2048 x 1536 pixels
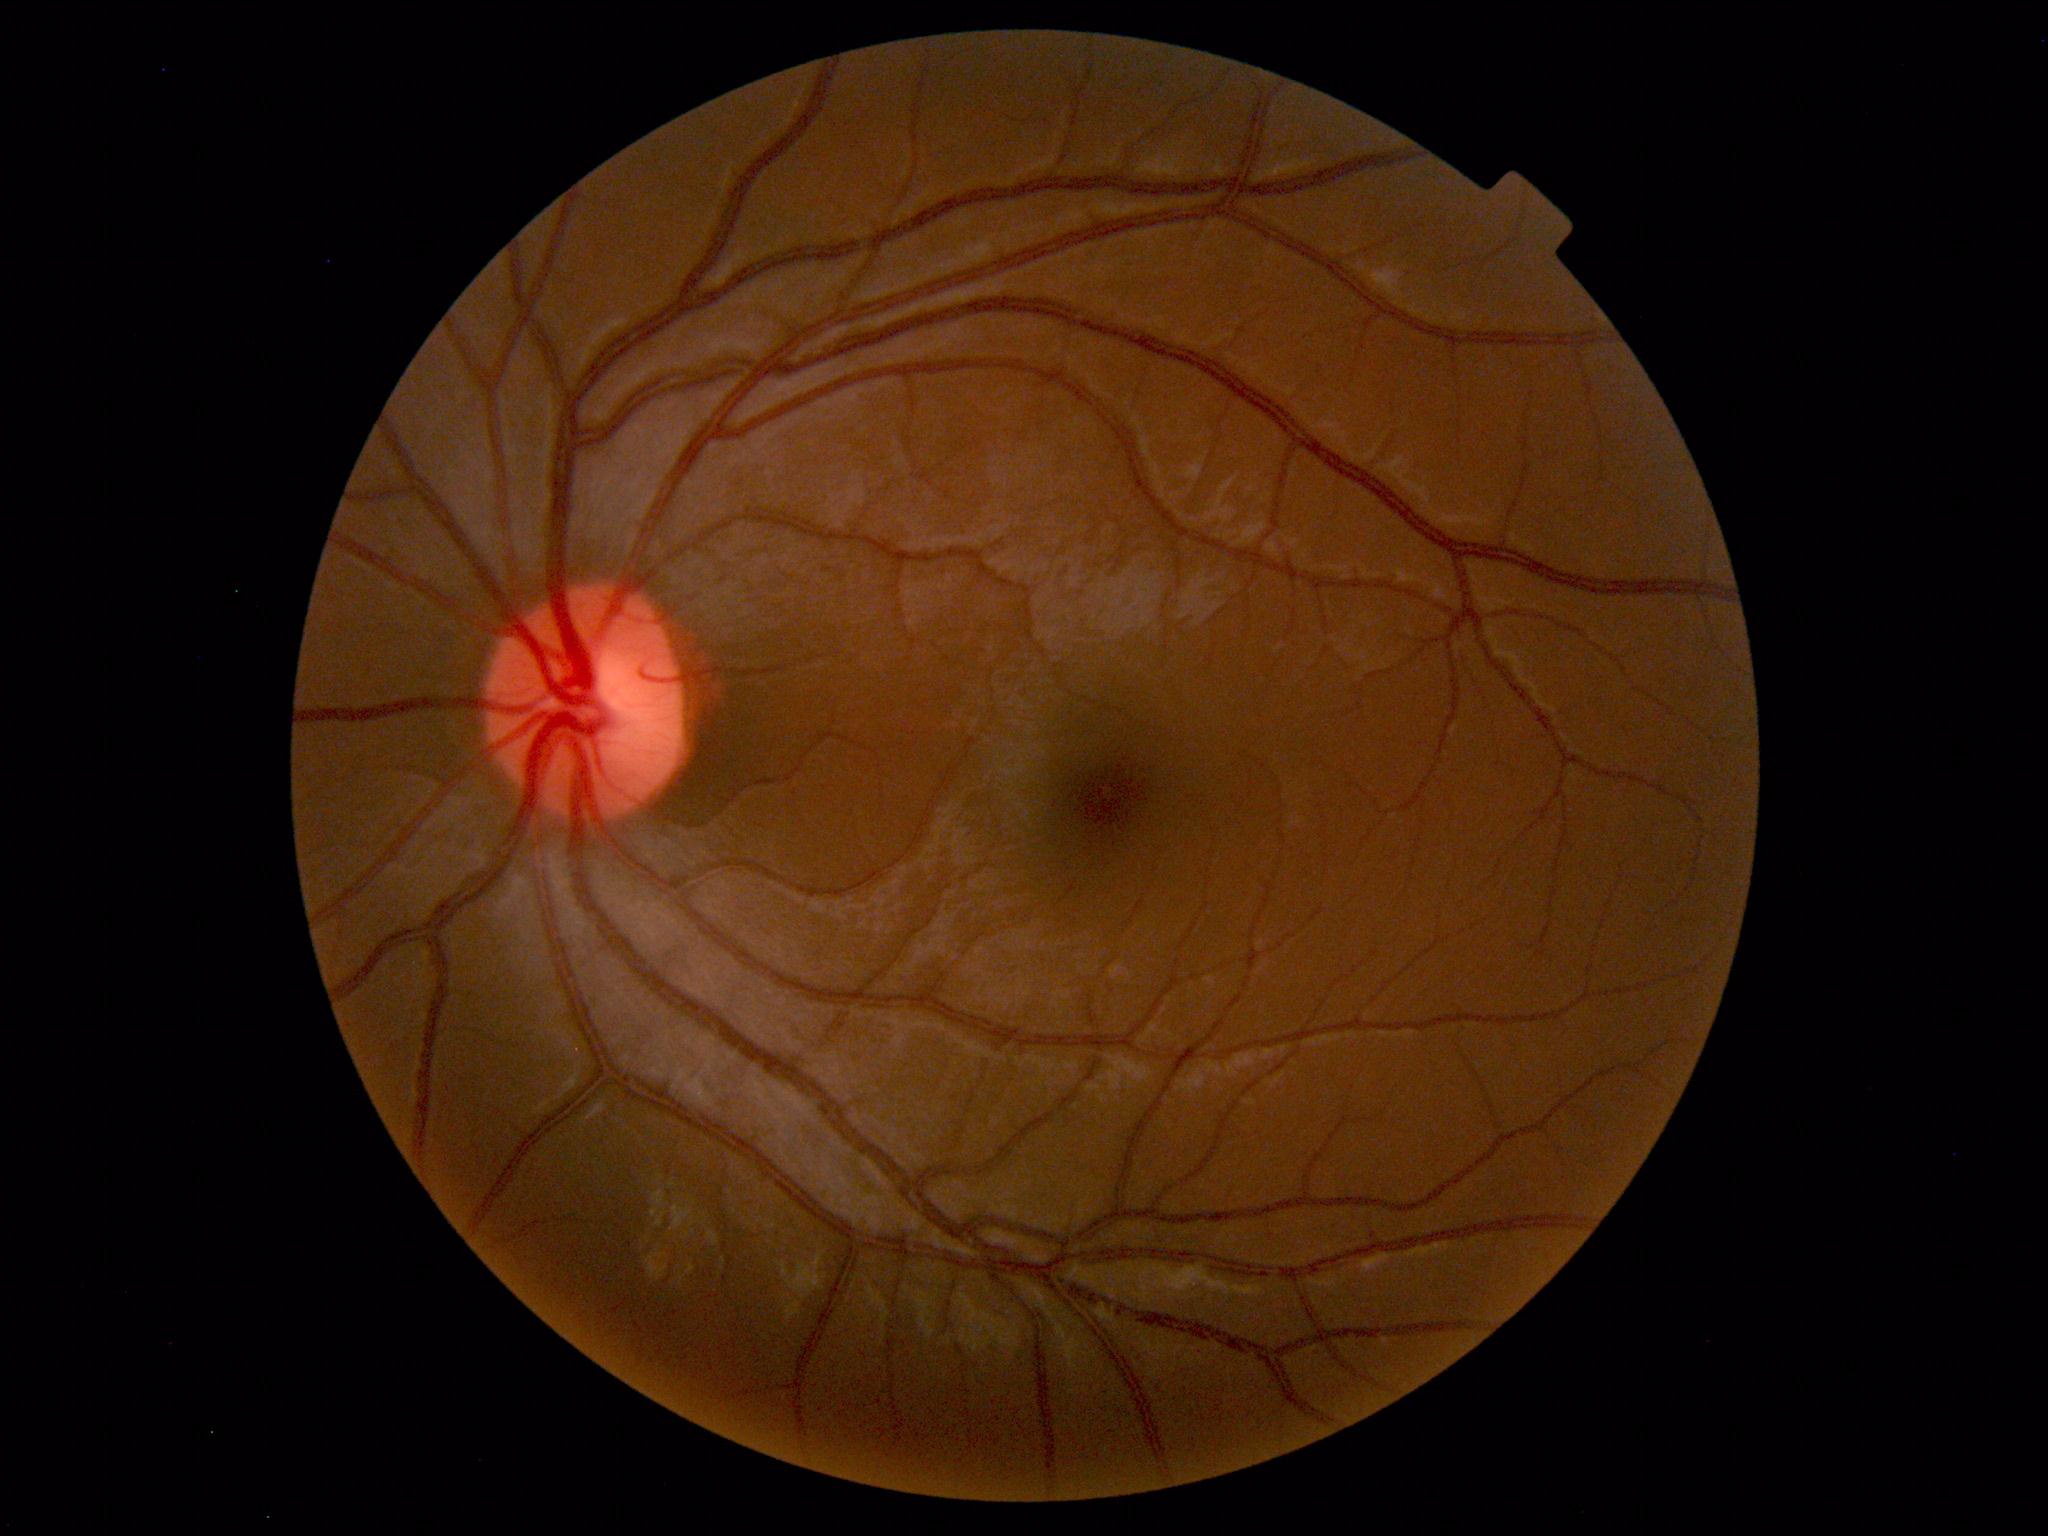

Normal fundus. No pathology identified.